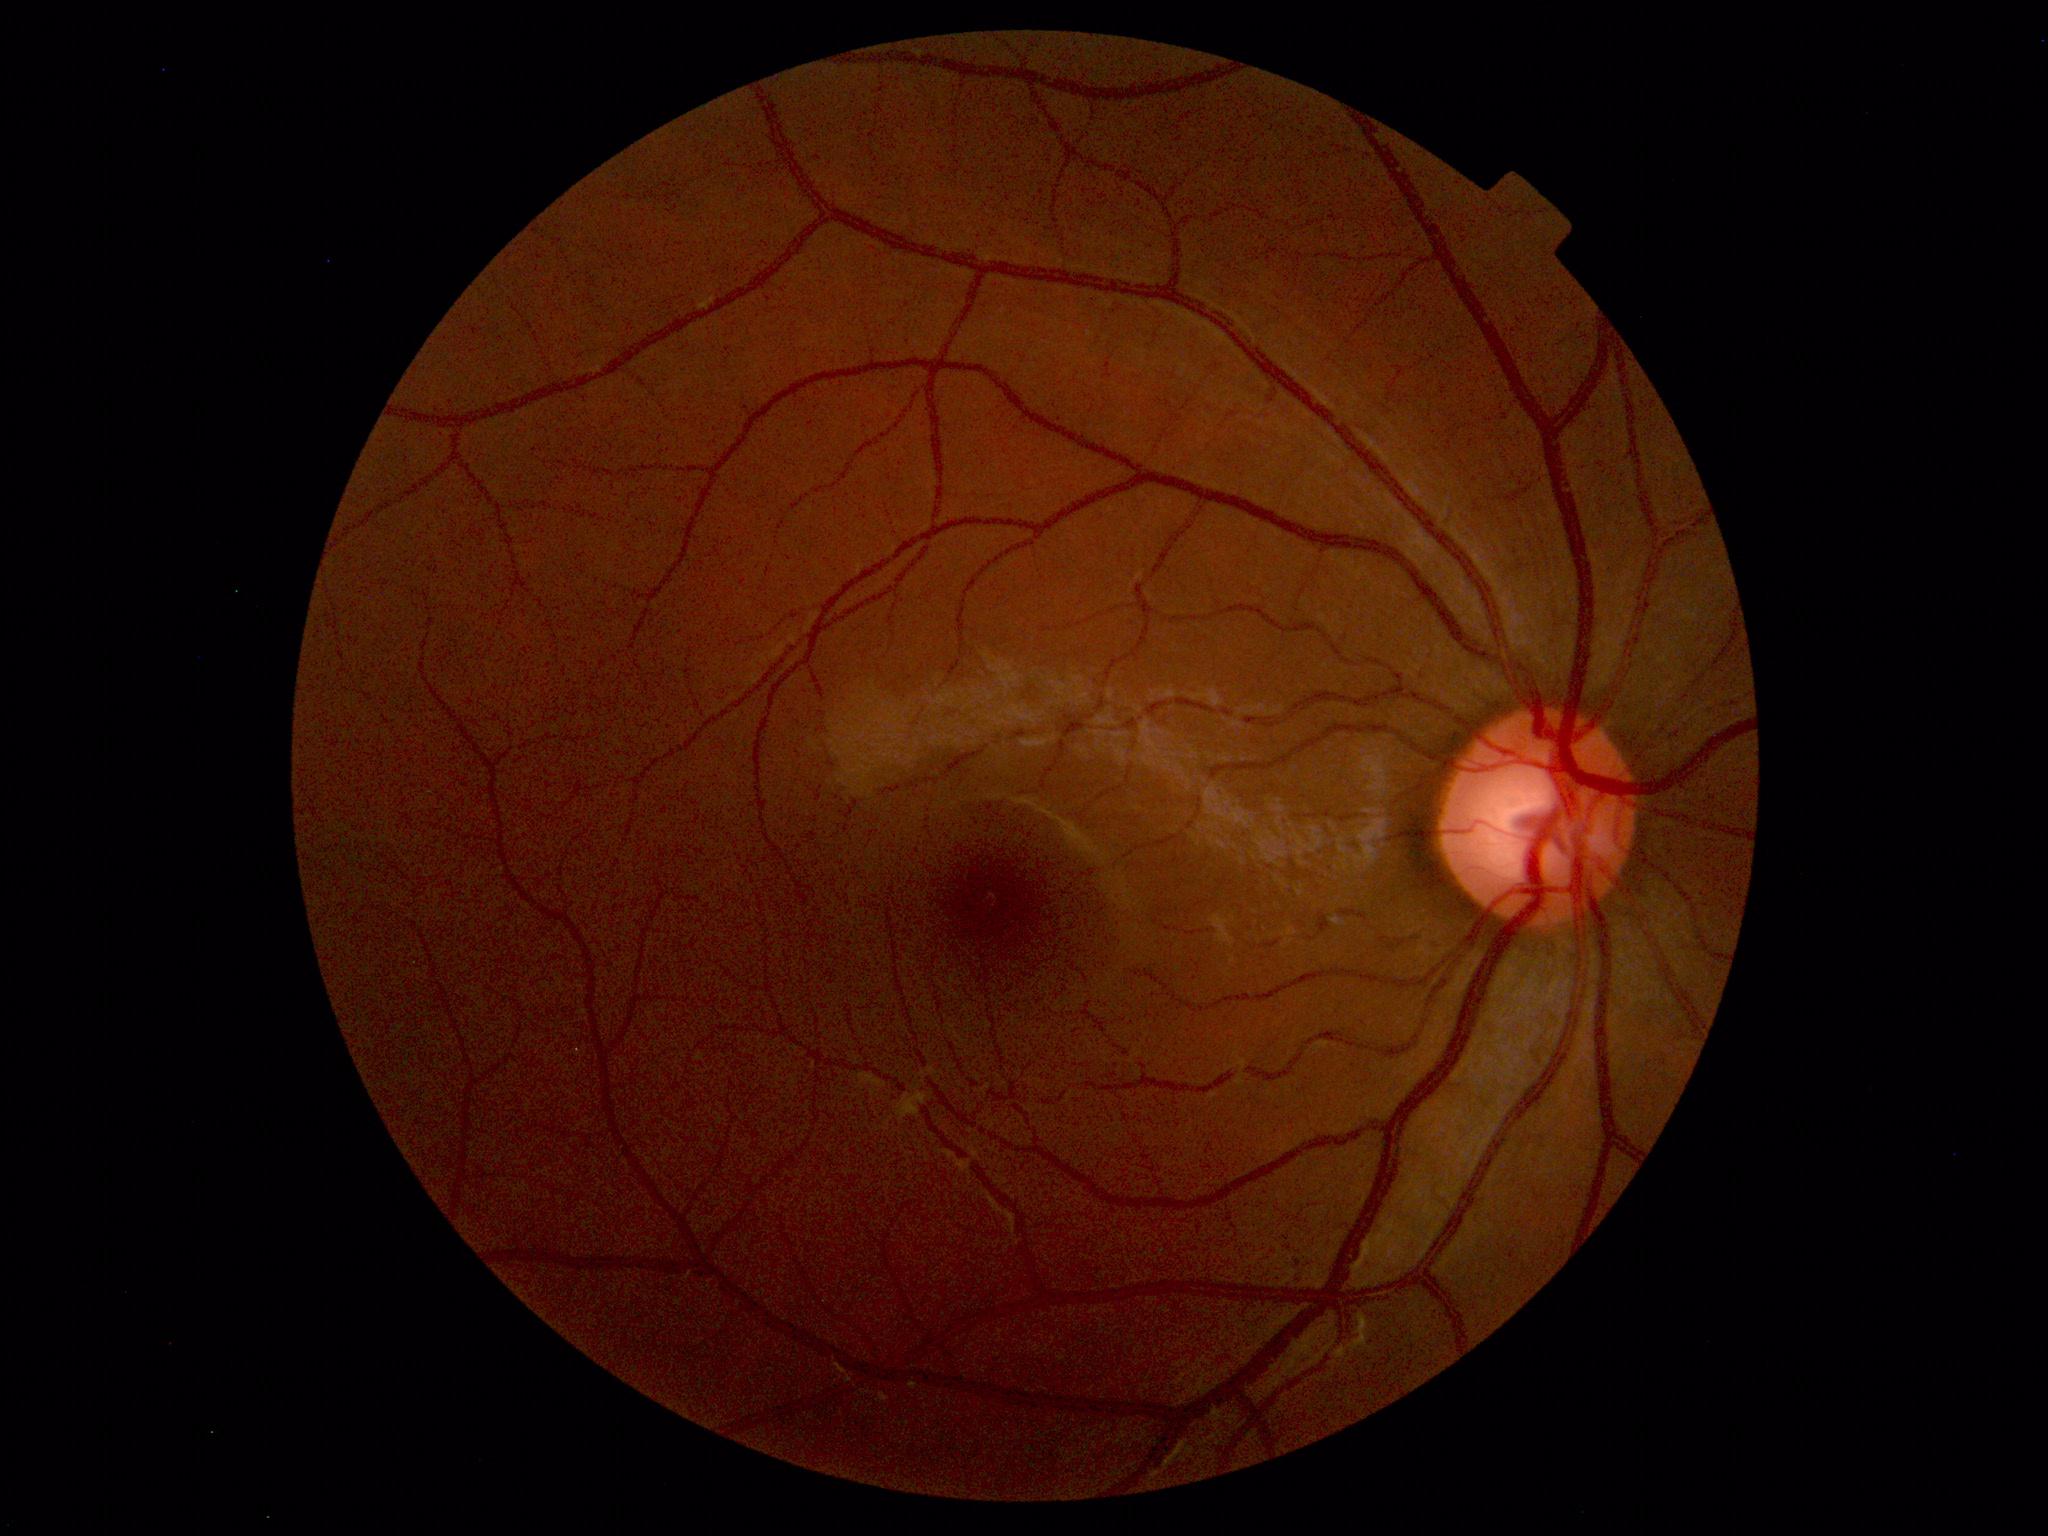
Diagnosis: normal.